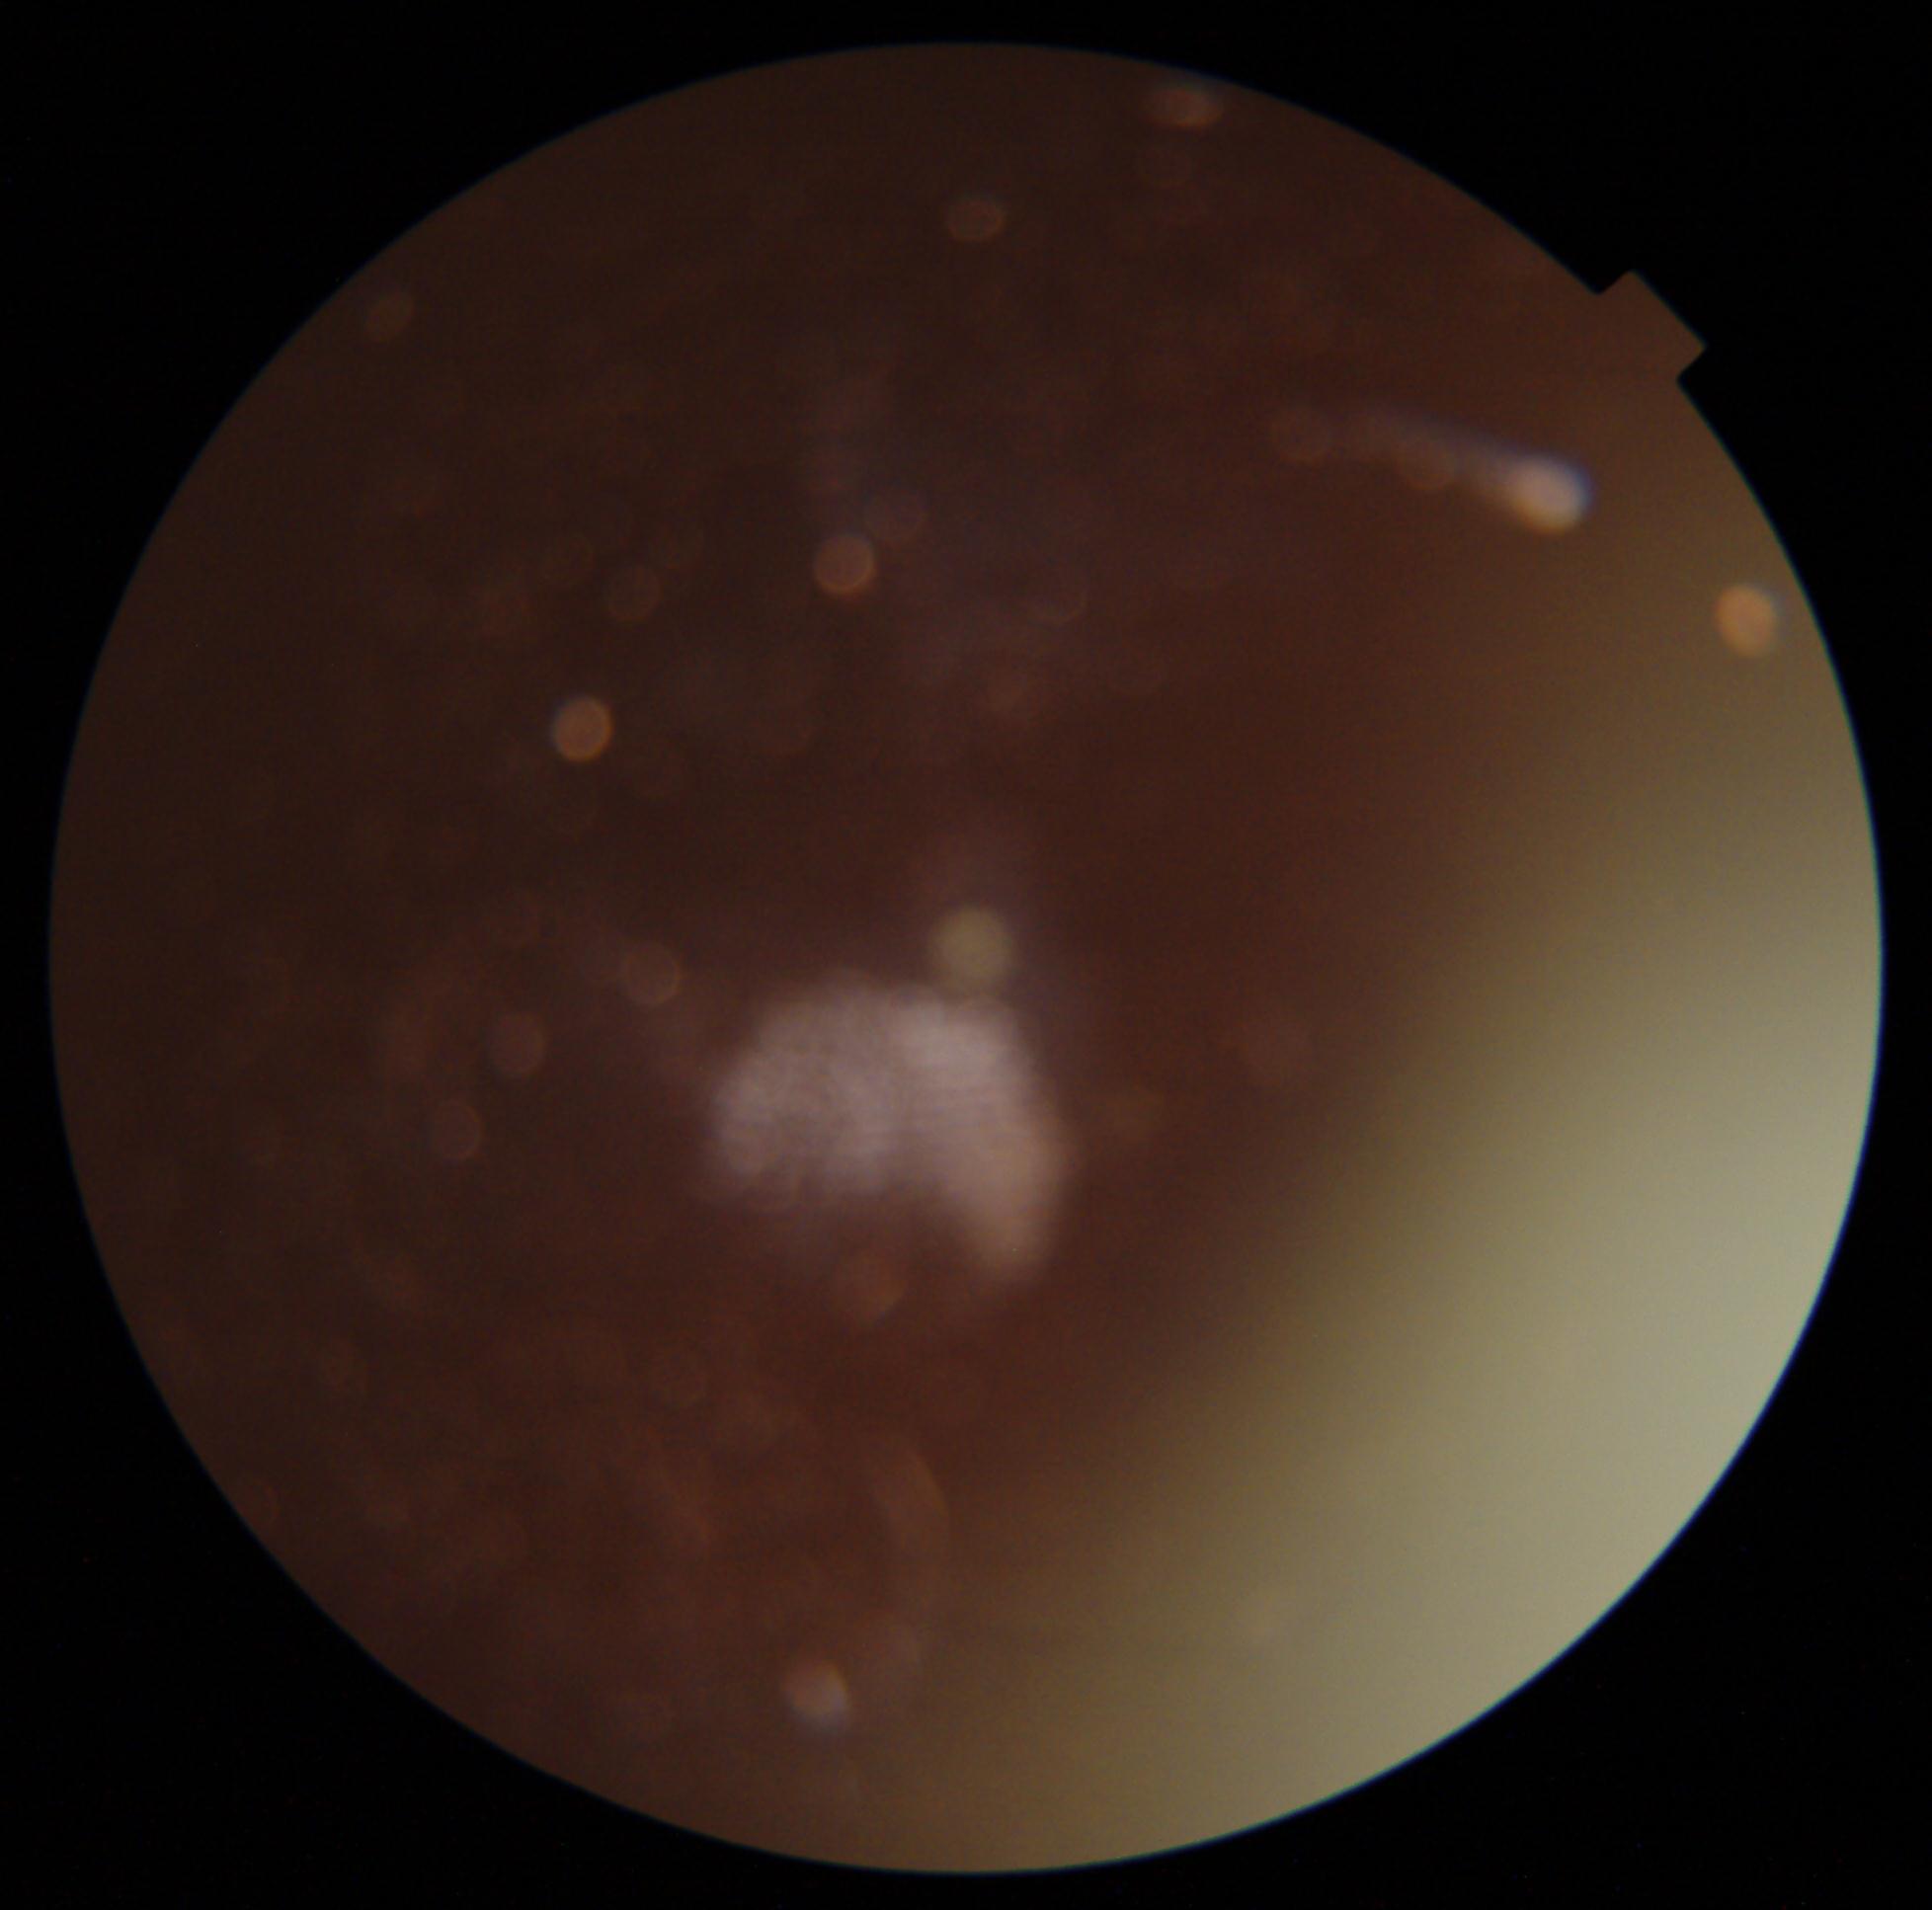
Annotations:
– DR severity: ungradable due to poor image quality
– image quality: insufficient